2048x1536 — 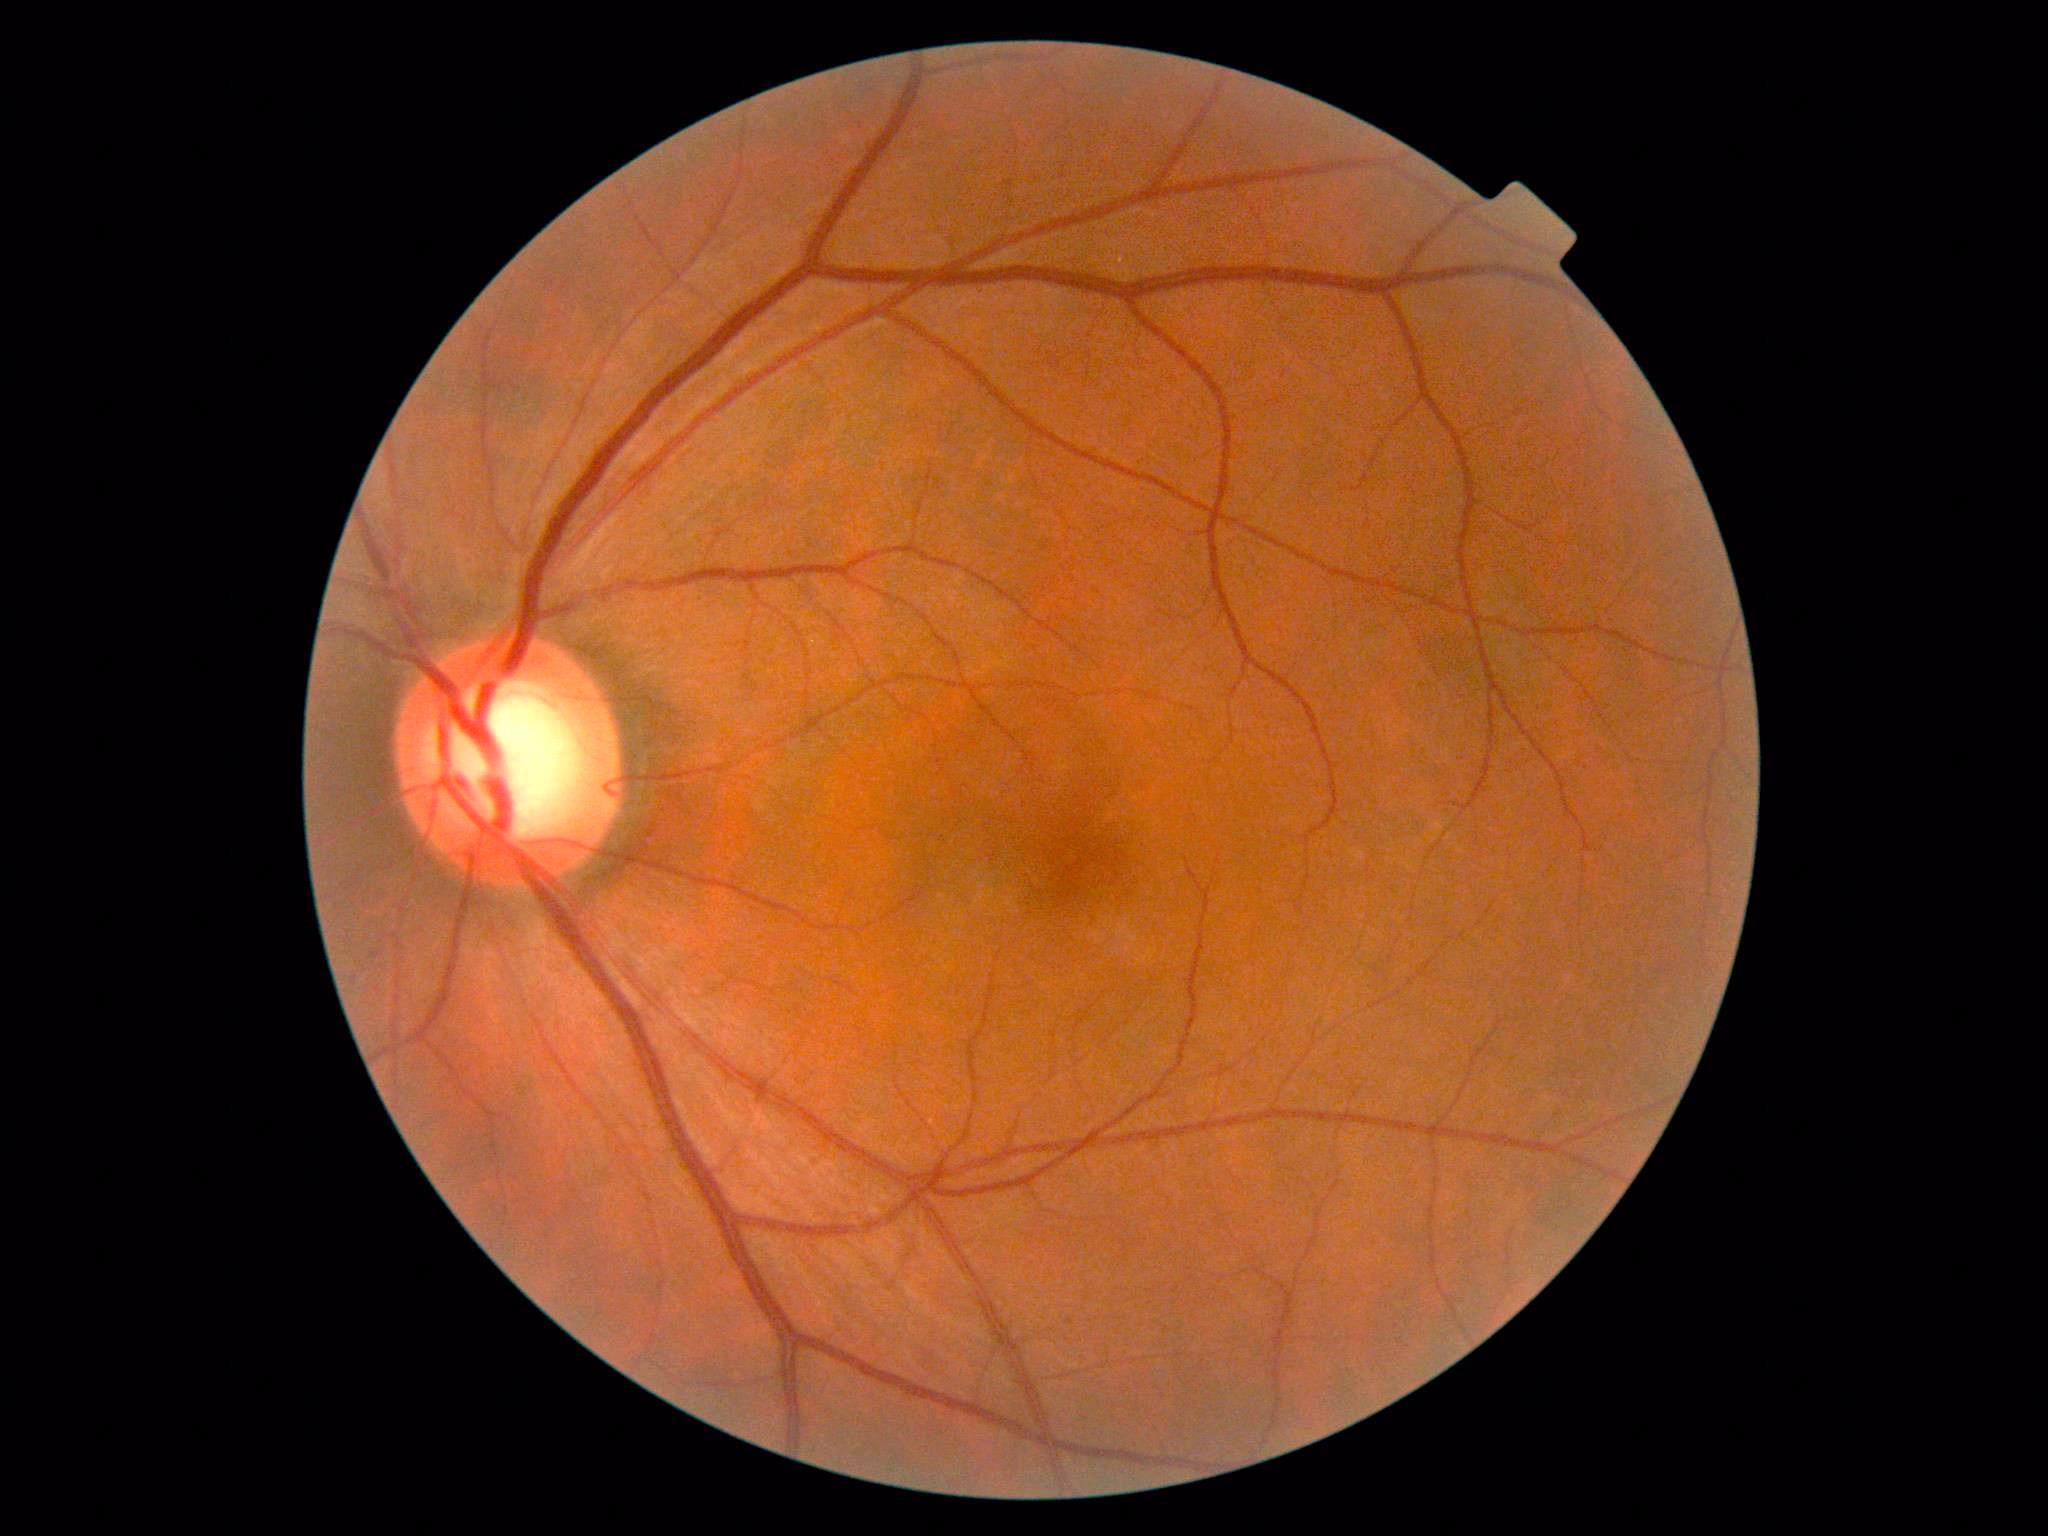 Annotations:
* DR grade — 0 — no visible signs of diabetic retinopathy